Optic disc region crop. Color fundus photograph. 240x240px: 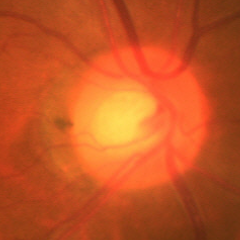
Glaucoma status = early glaucoma.